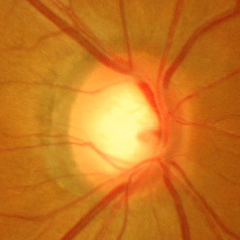
Glaucoma diagnosis = advanced-stage glaucoma.